No pharmacologic dilation · 848x848px · retinal fundus photograph.
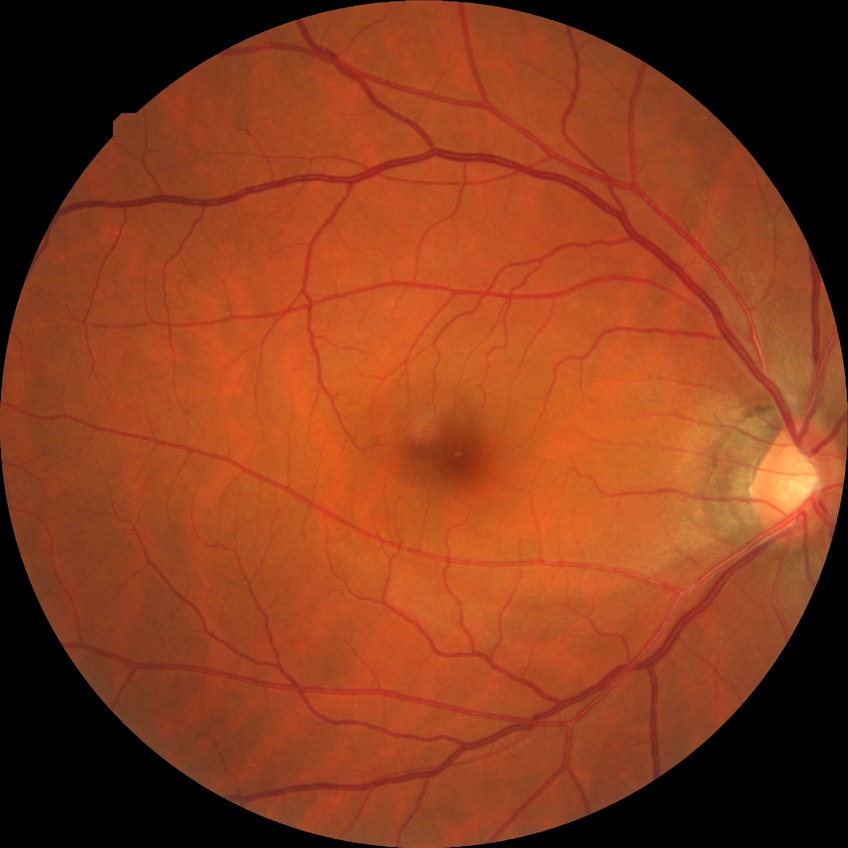 Davis DR grade is NDR.